Fundus photo — 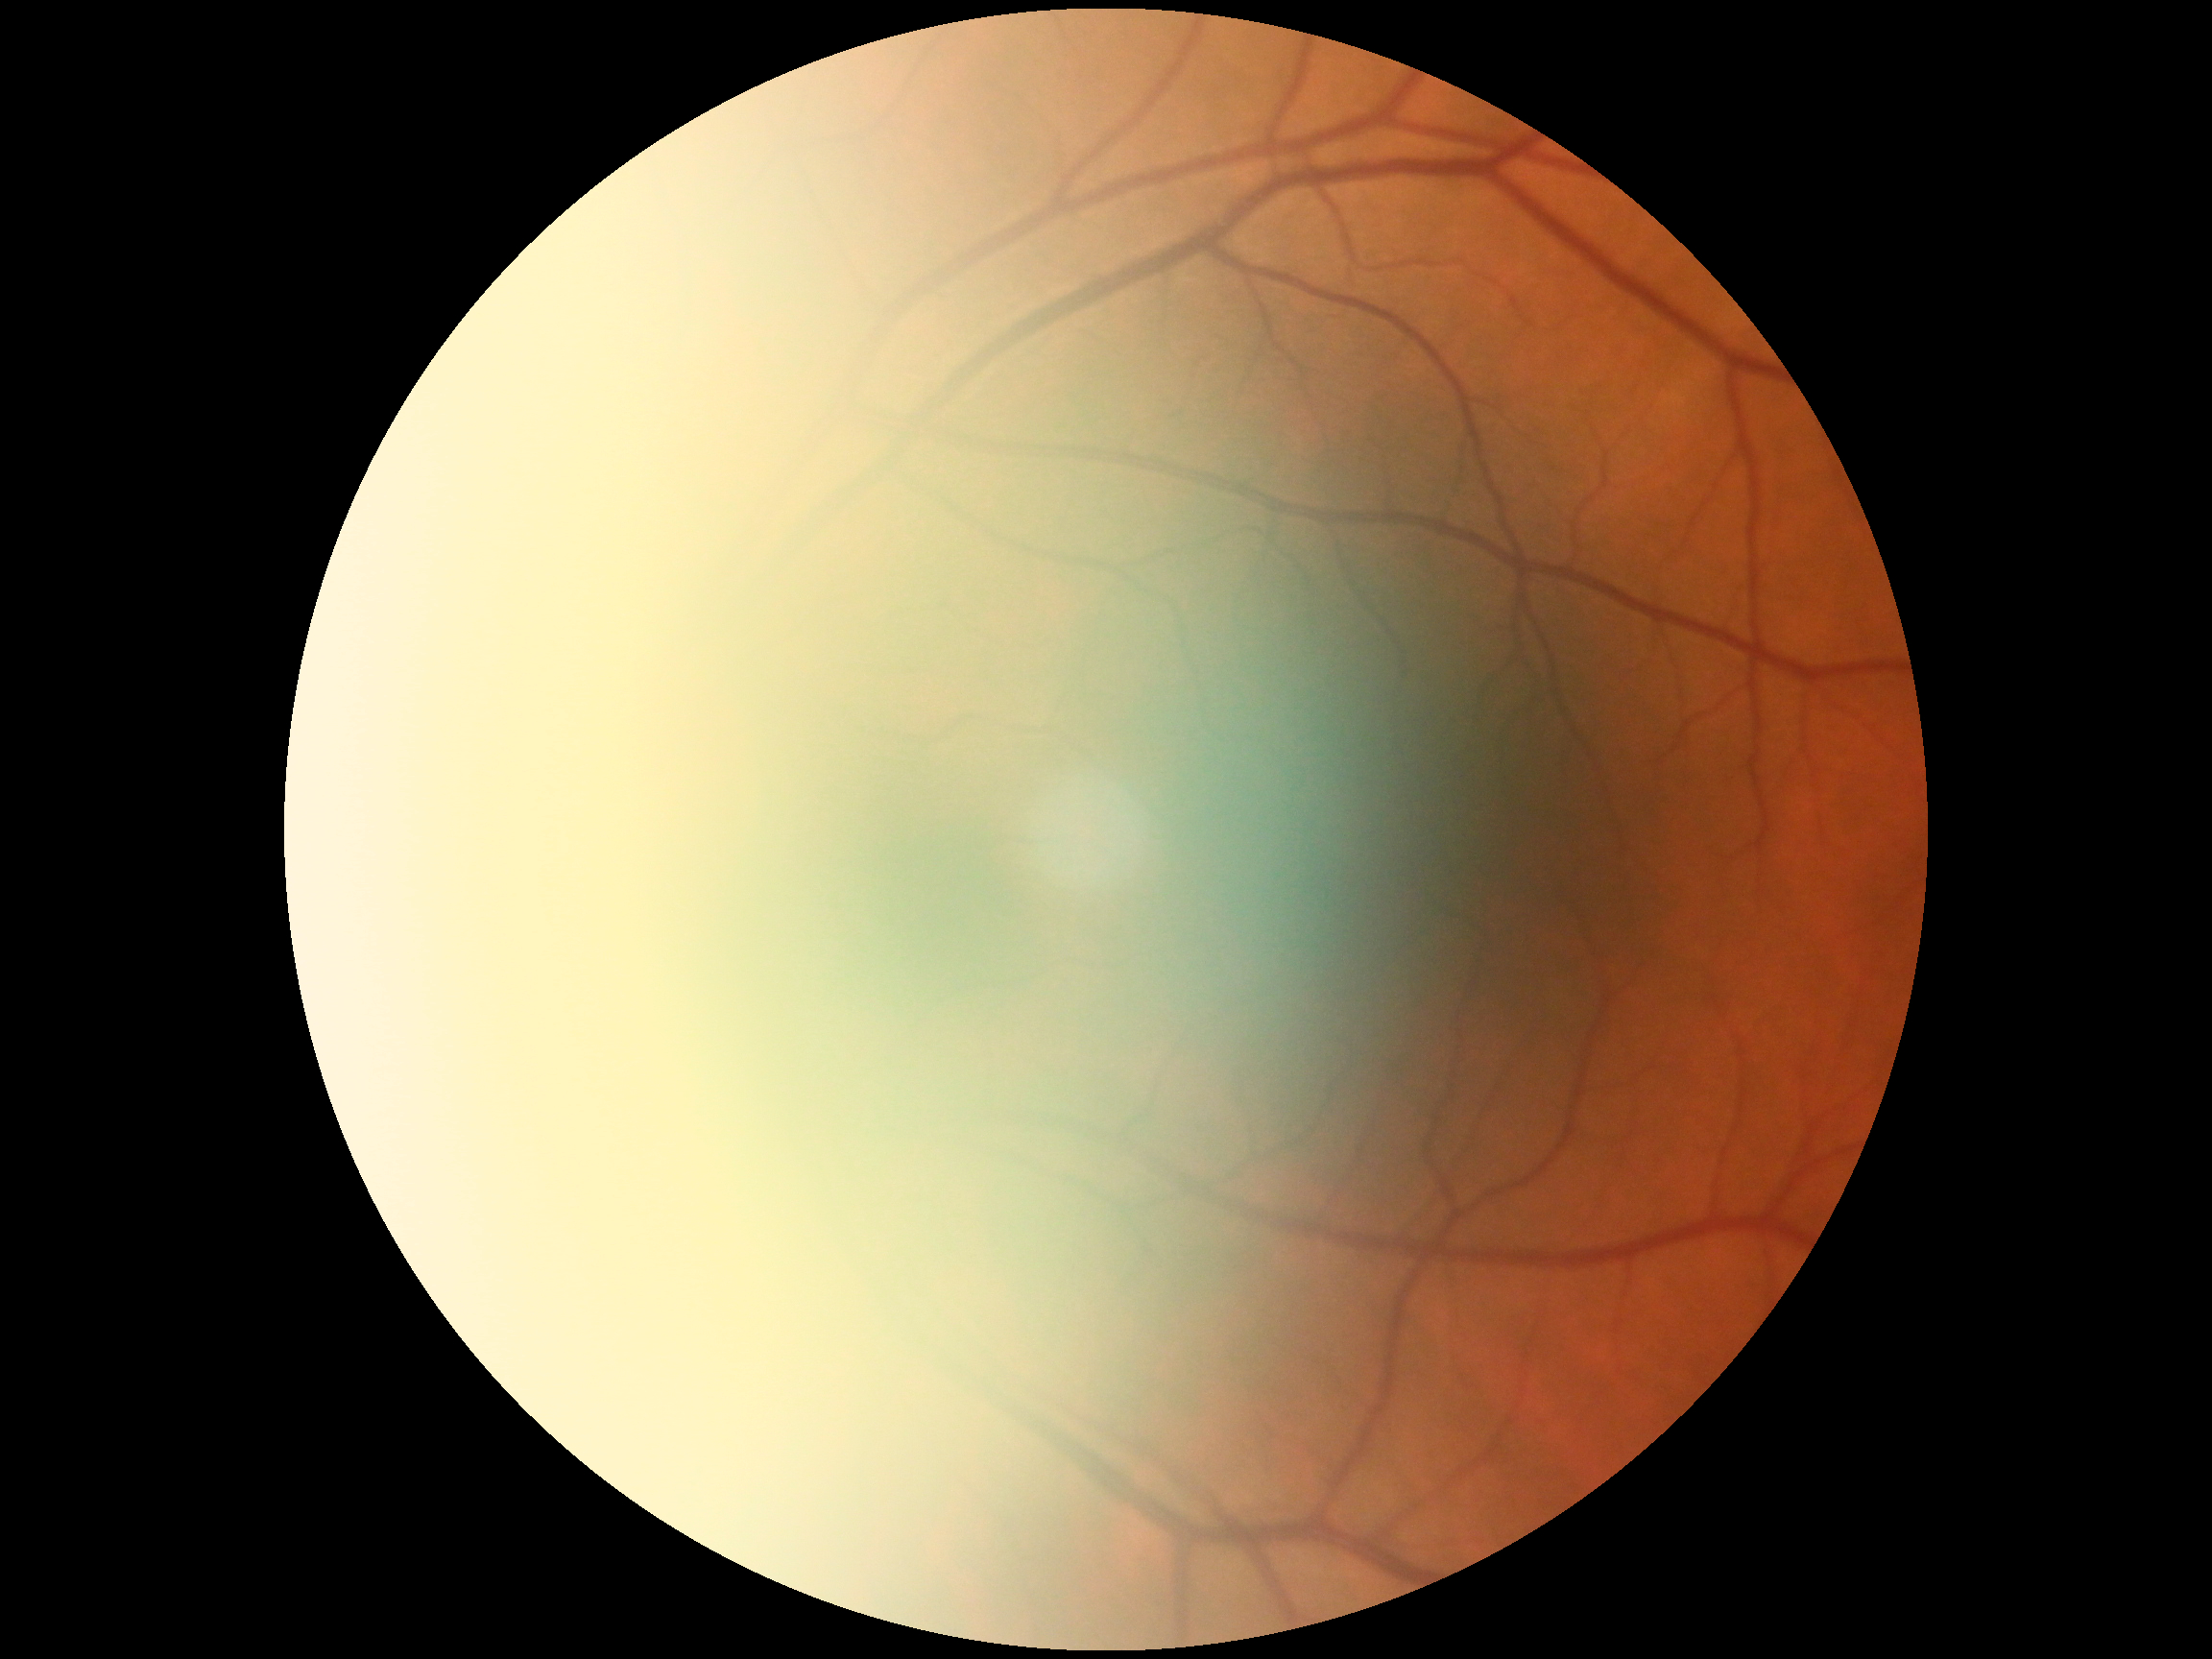 Diabetic retinopathy severity is grade 0 (no apparent retinopathy). No apparent diabetic retinopathy.